848 x 848 pixels, modified Davis classification, retinal fundus photograph:
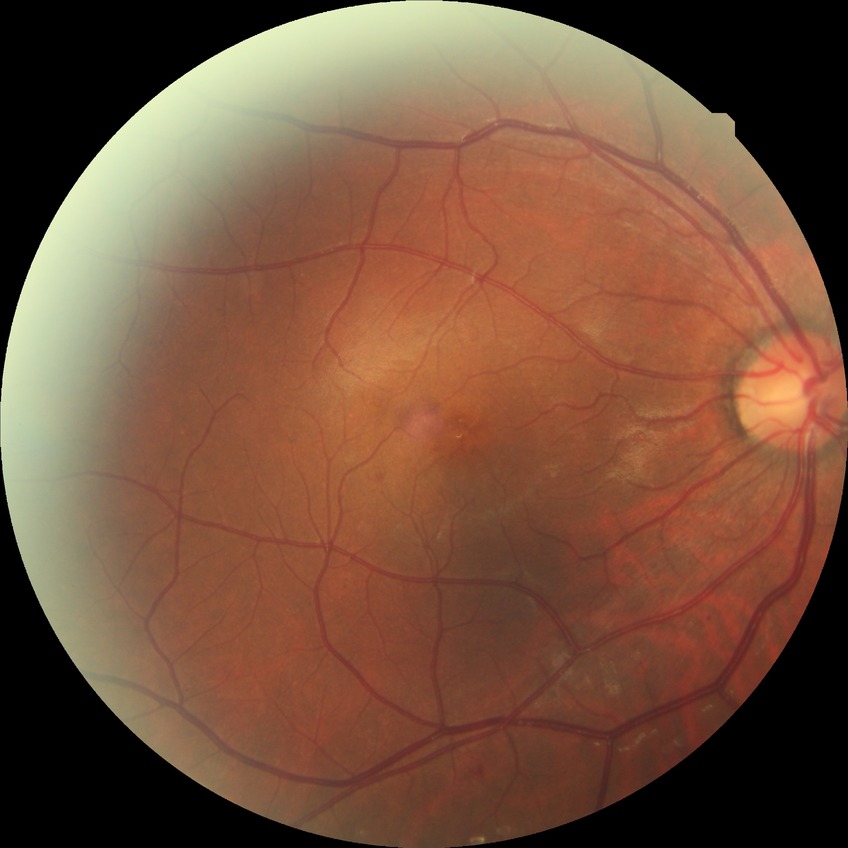
Davis grading: simple diabetic retinopathy.